FOV: 45 degrees: 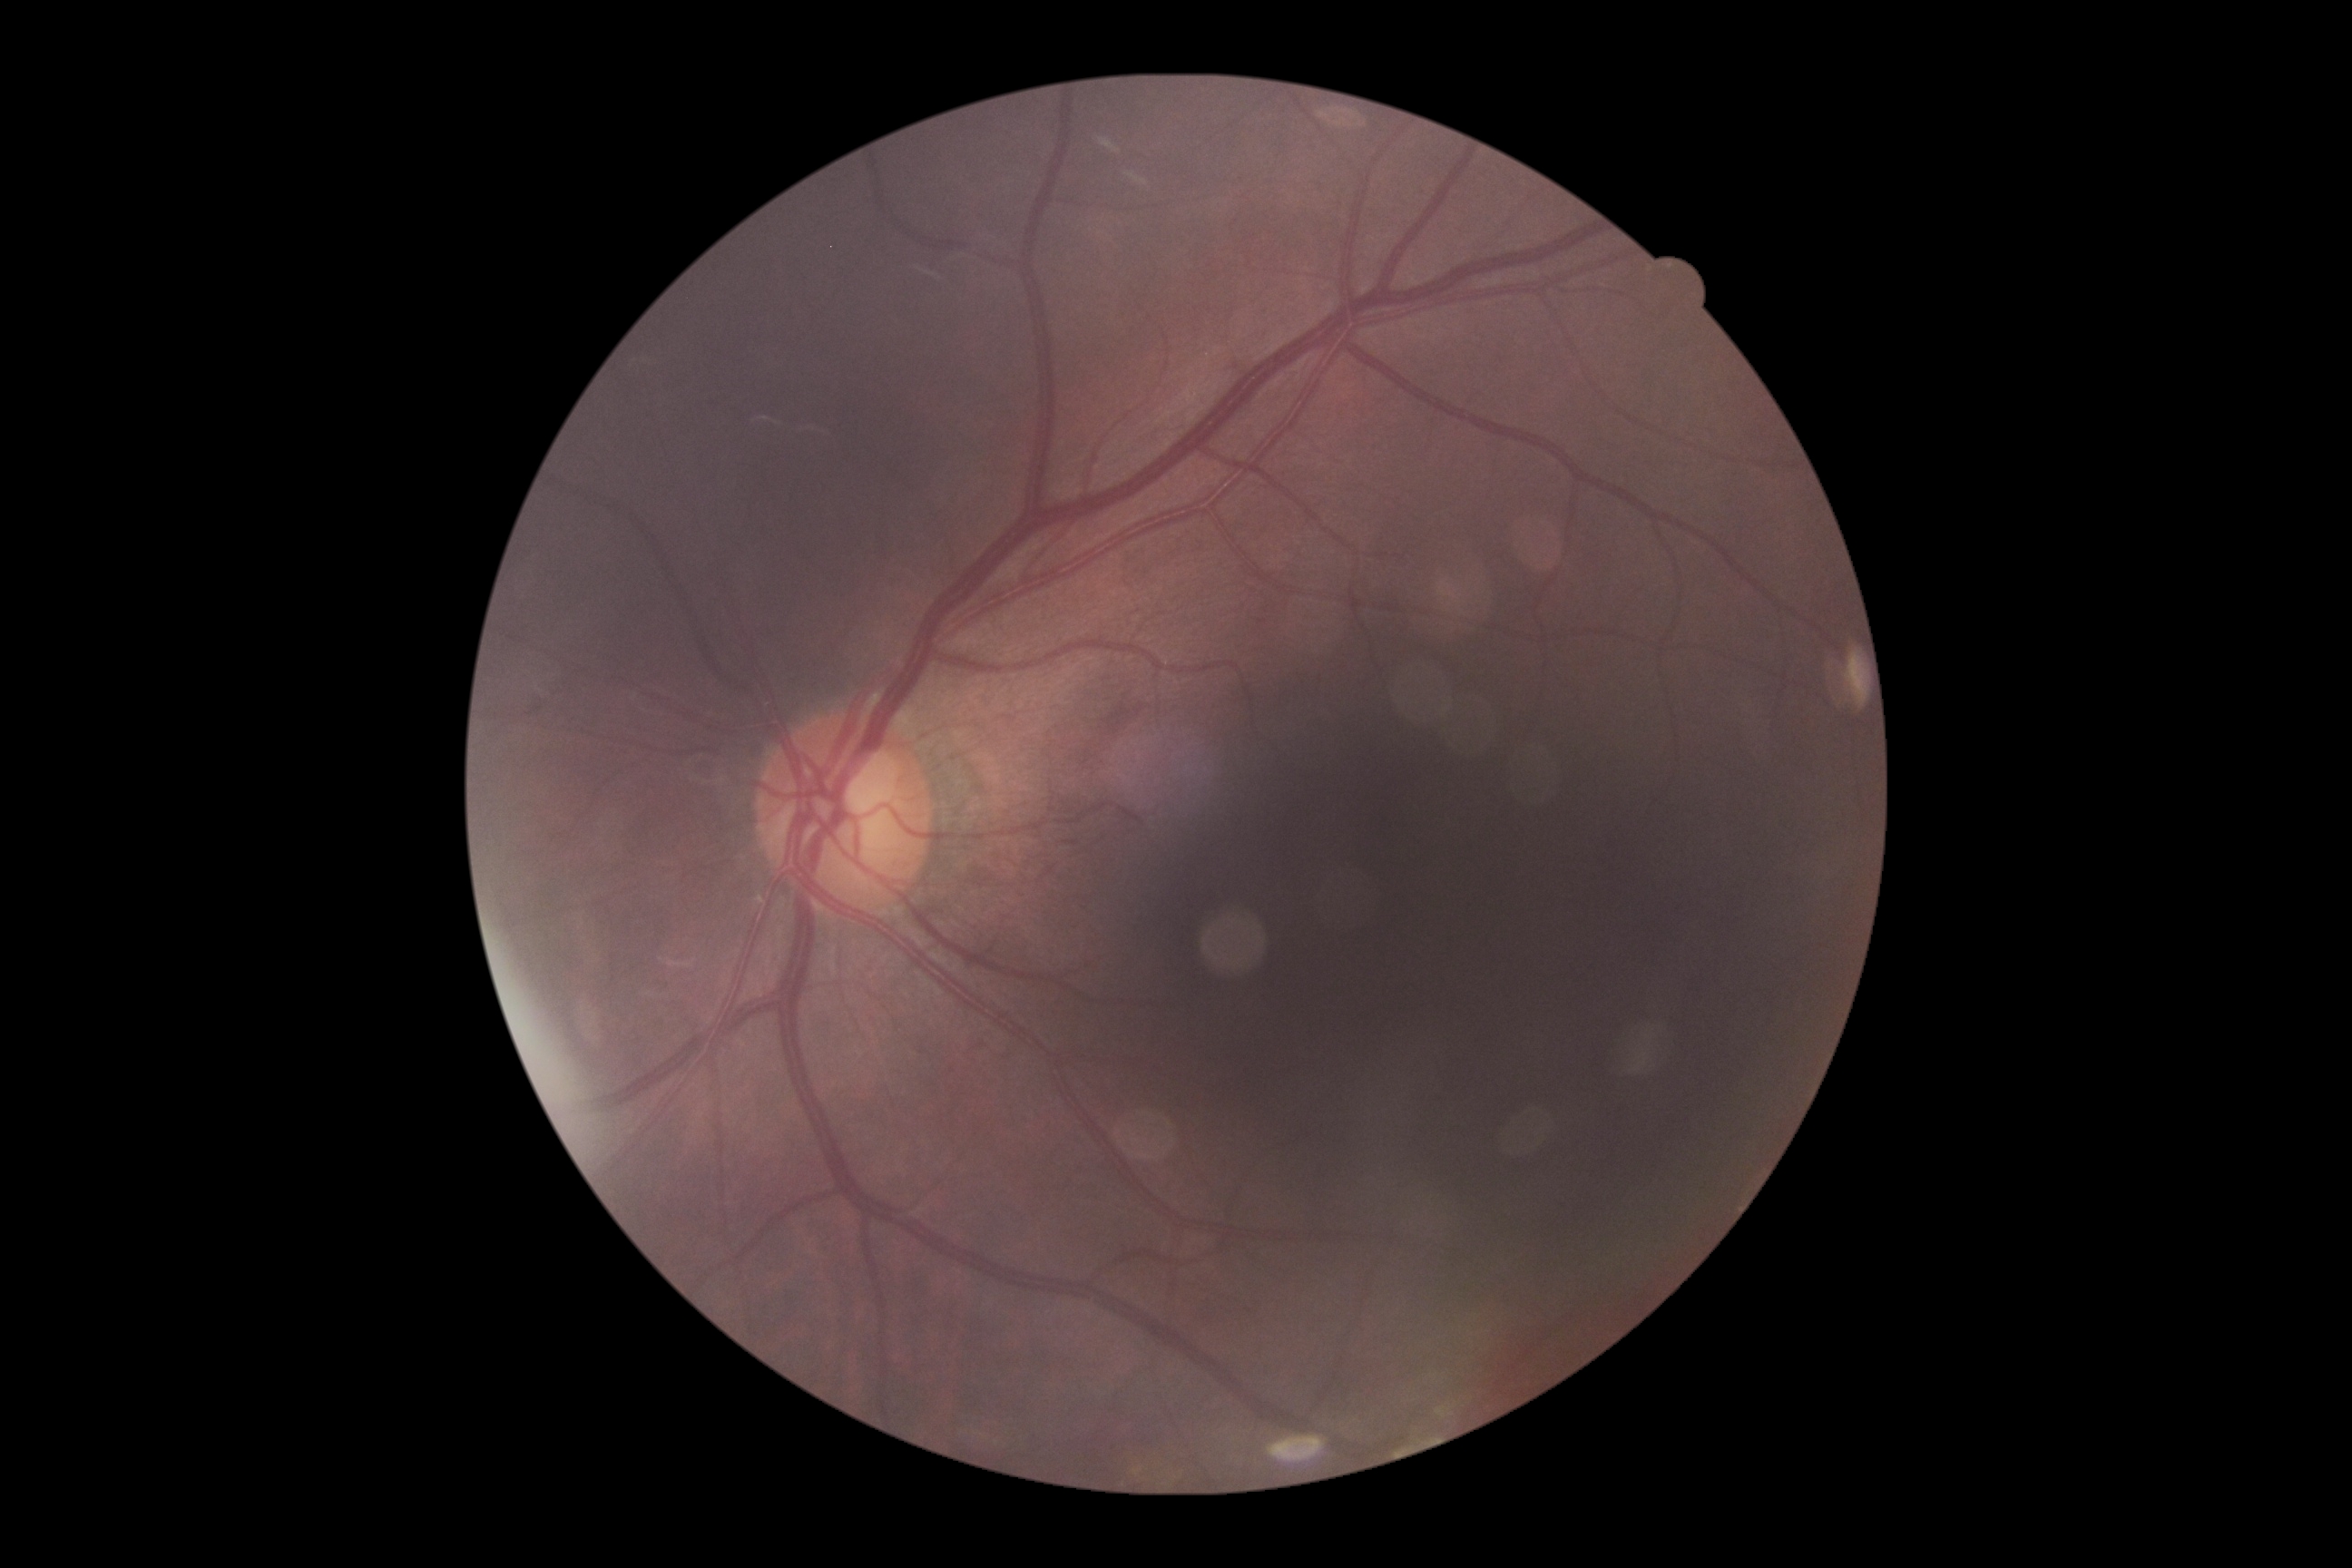

DR class = non-proliferative diabetic retinopathy
diabetic retinopathy (DR) = moderate NPDR (grade 2)